No pharmacologic dilation: 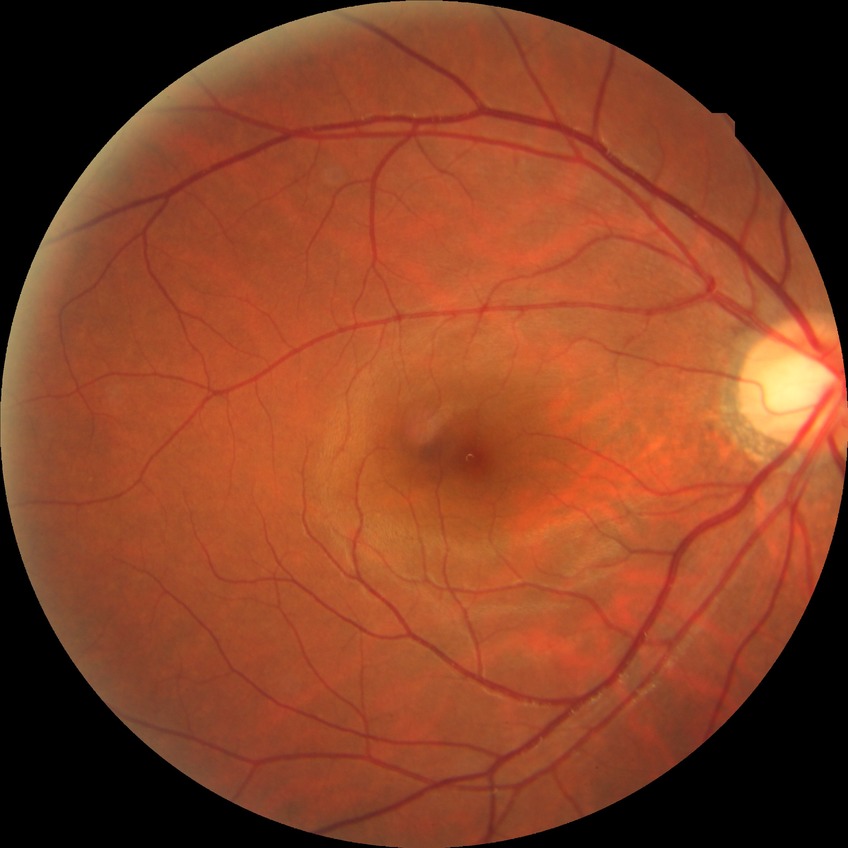

diabetic retinopathy (DR)=NDR (no diabetic retinopathy).